Color fundus photograph, optic disc-centered crop, 240 x 240 pixels
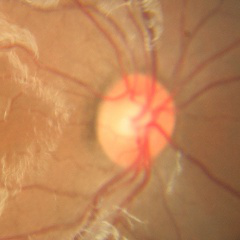
Glaucoma assessment = no evidence of glaucoma.